Graded on the modified Davis scale: 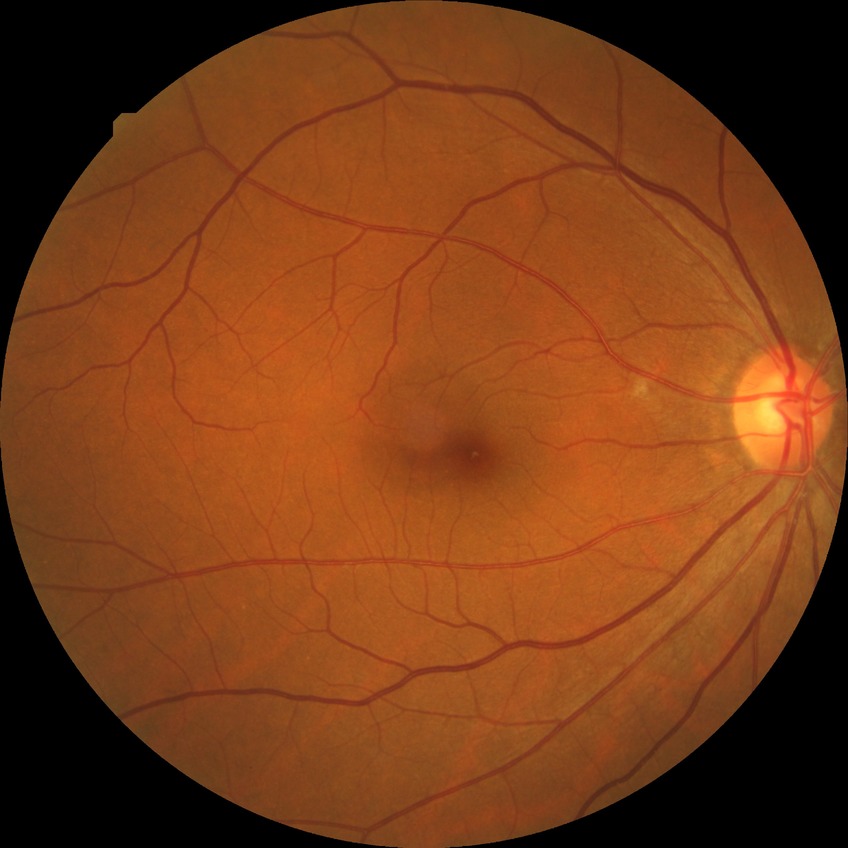
DR severity is NDR.